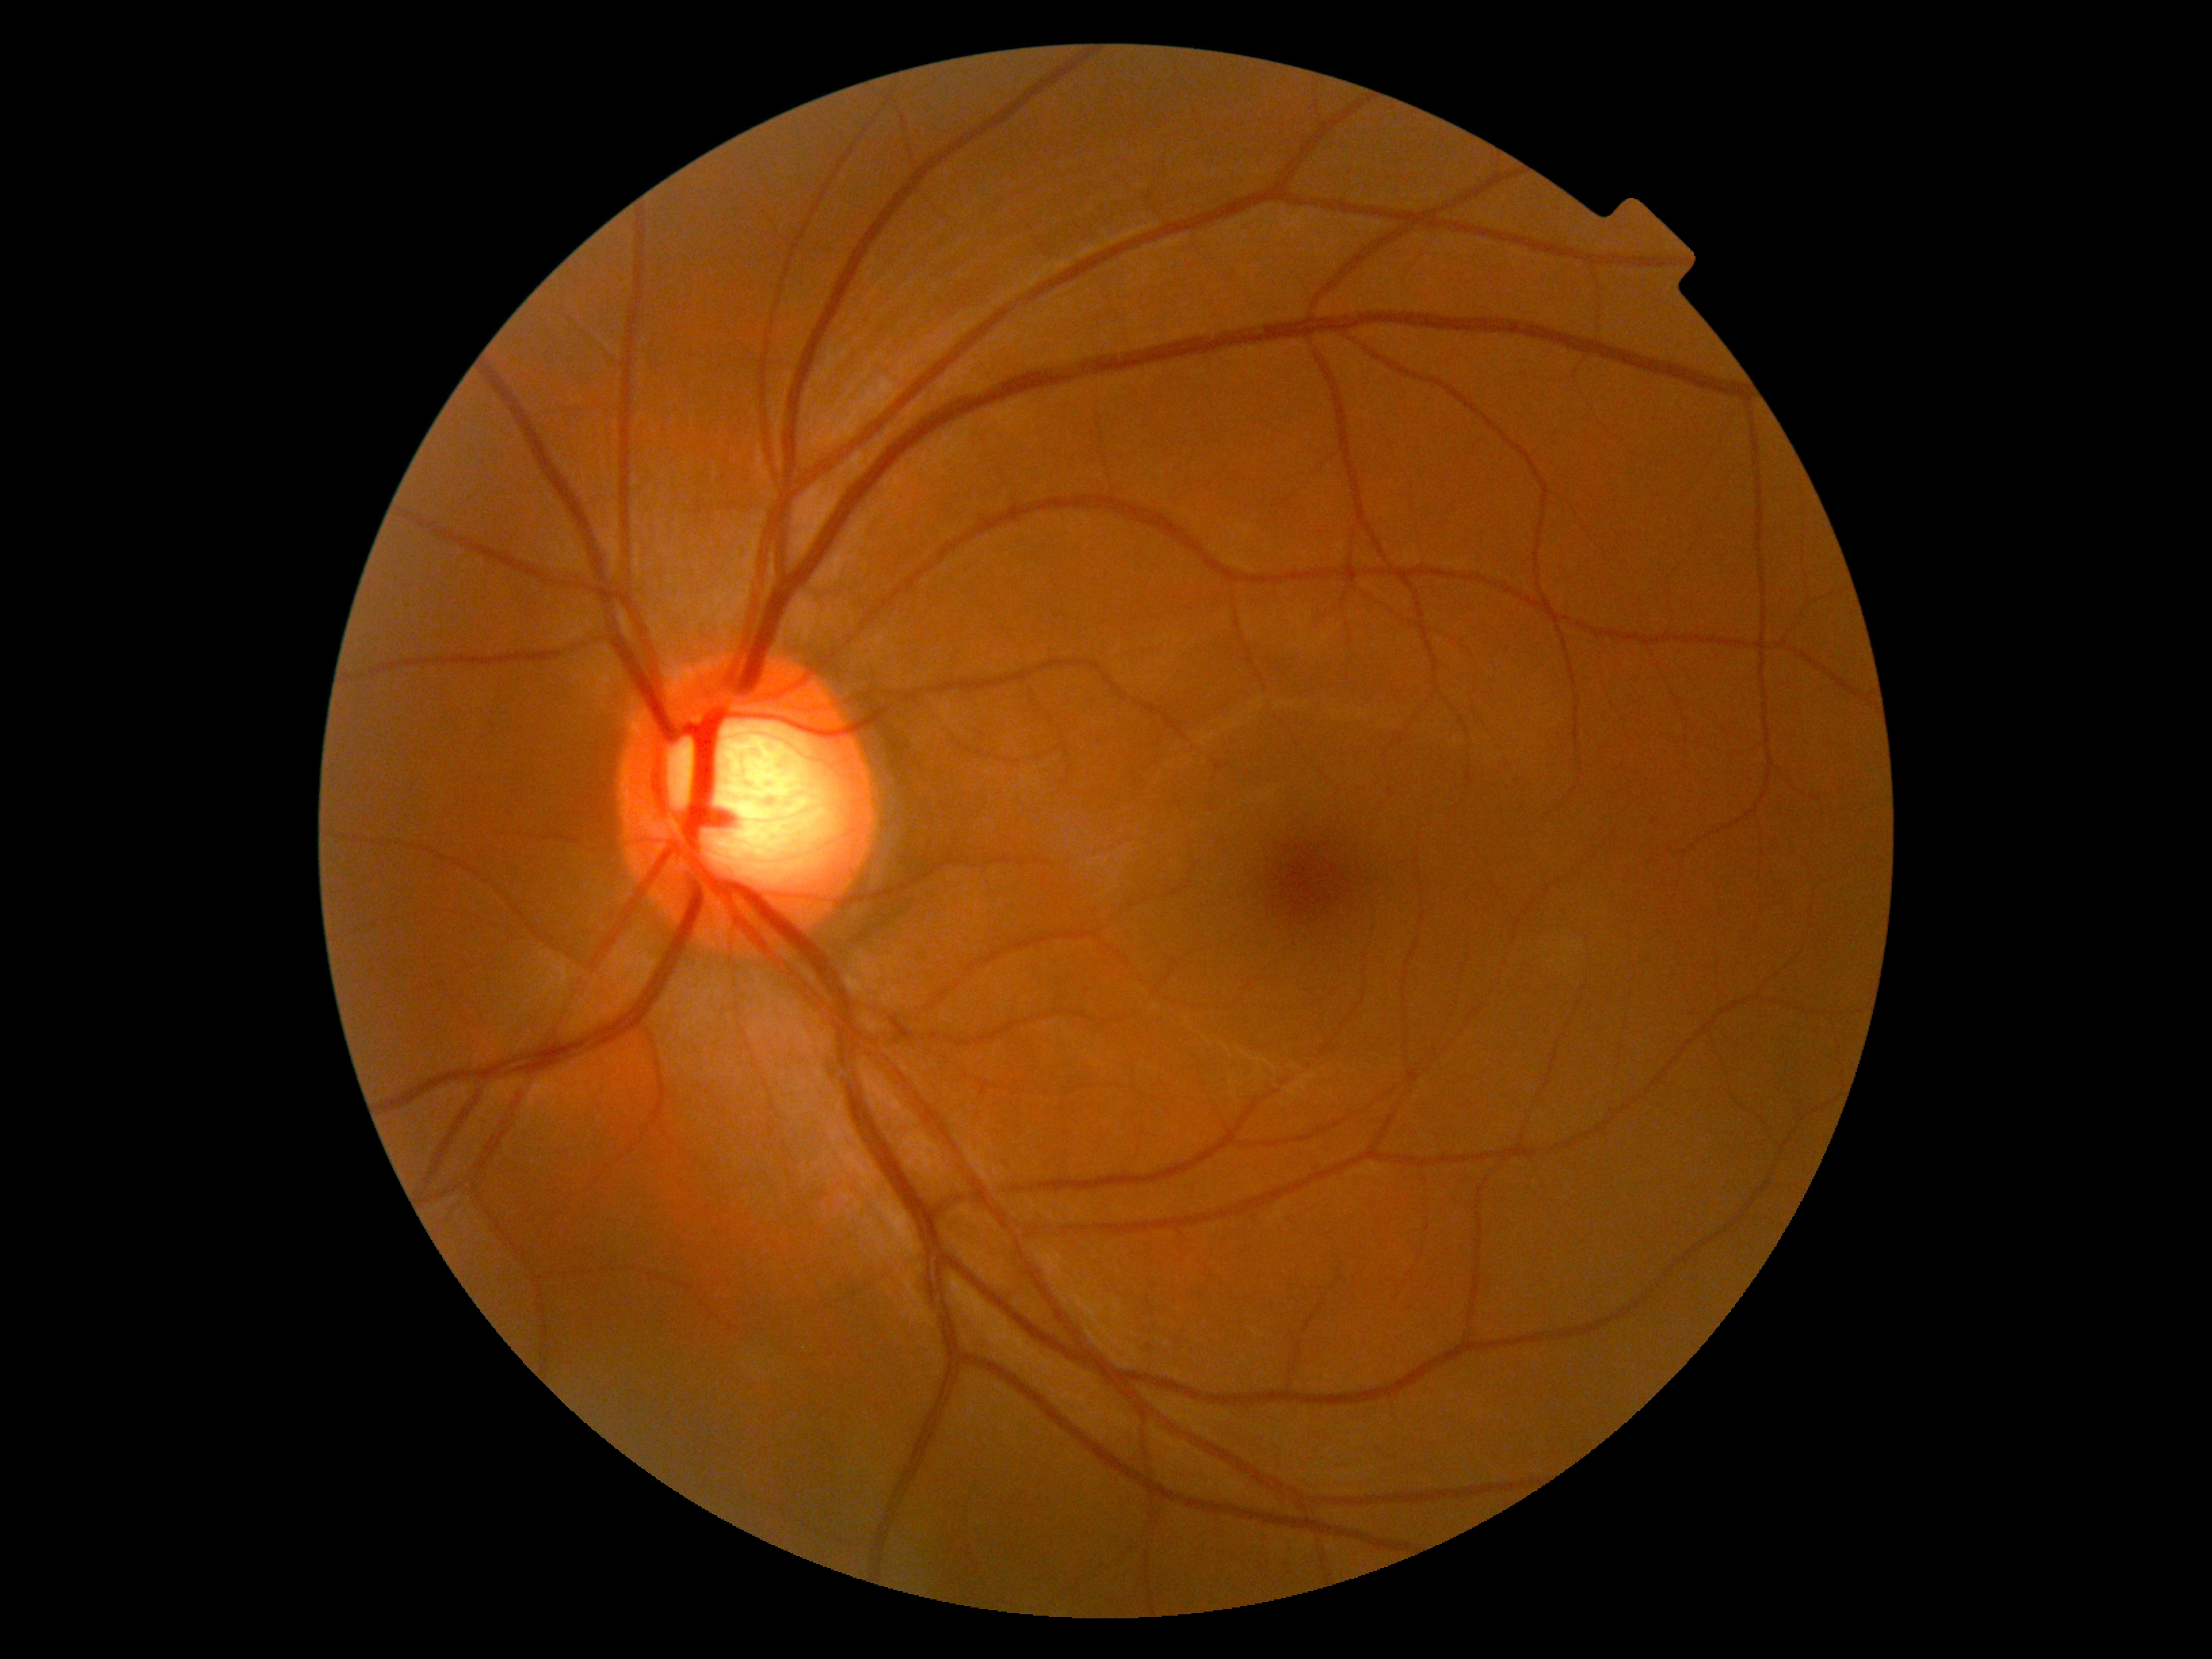

DR severity is grade 0 (no apparent retinopathy).
No apparent diabetic retinopathy.